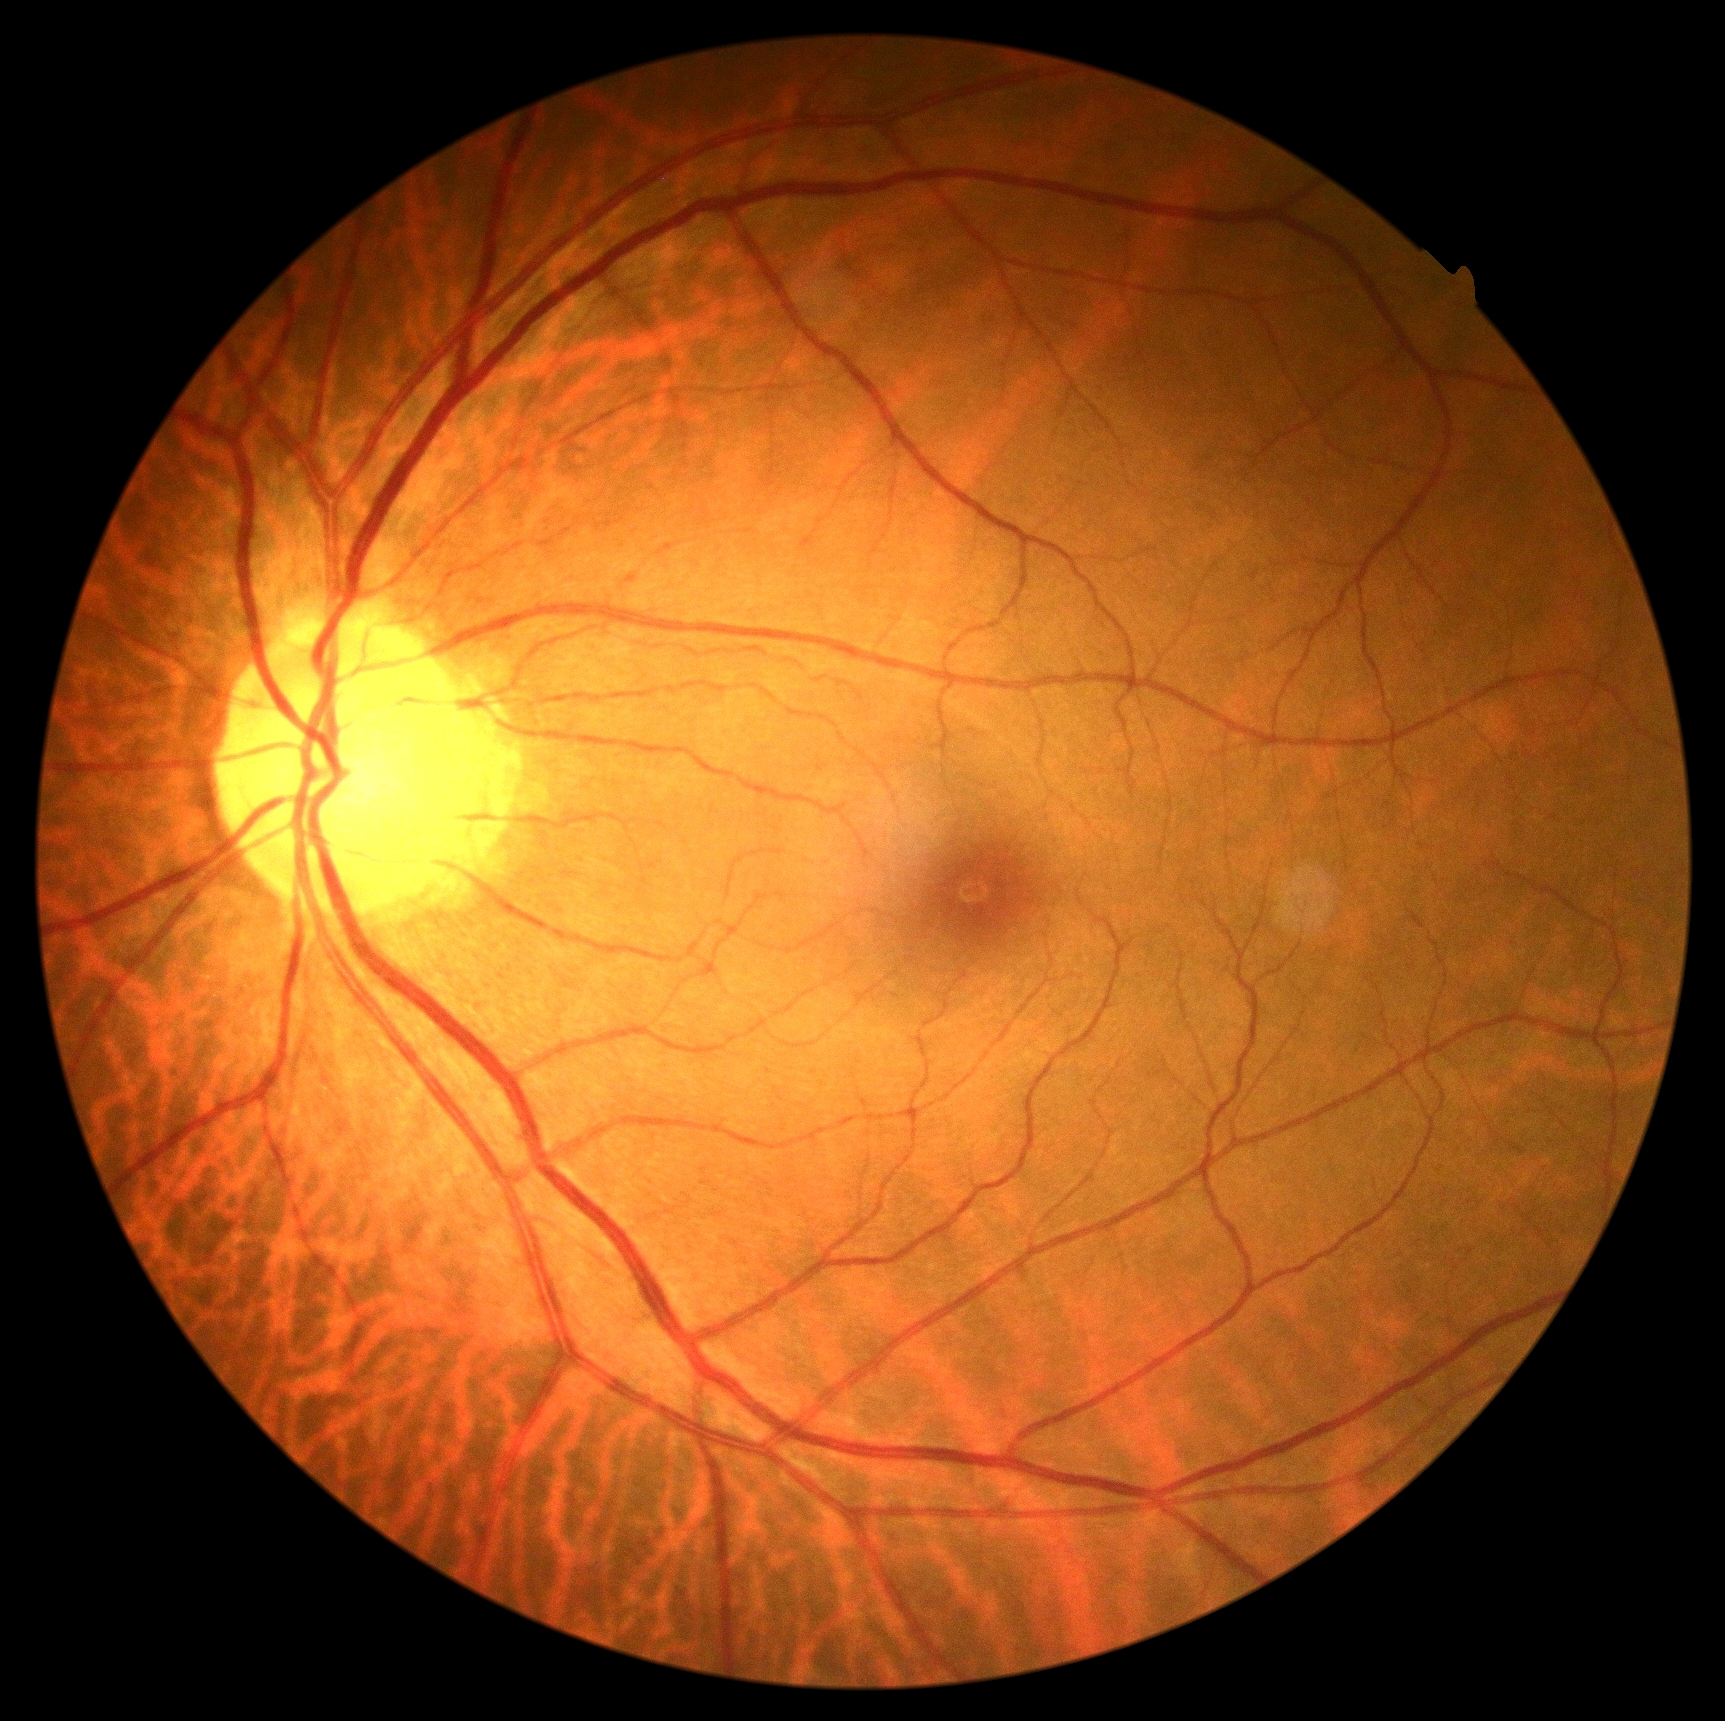

DR stage: grade 0 (no apparent retinopathy).